Pediatric wide-field fundus photograph; 640 by 480 pixels.
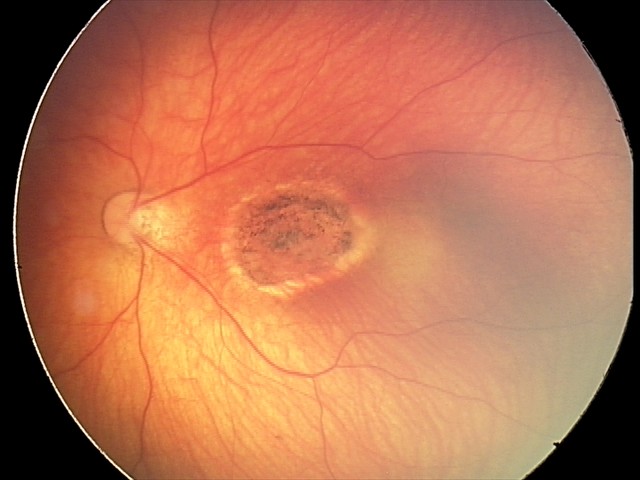

Screening series with toxoplasmosis chorioretinitis.